Diabetic retinopathy graded by the modified Davis classification; 848x848: 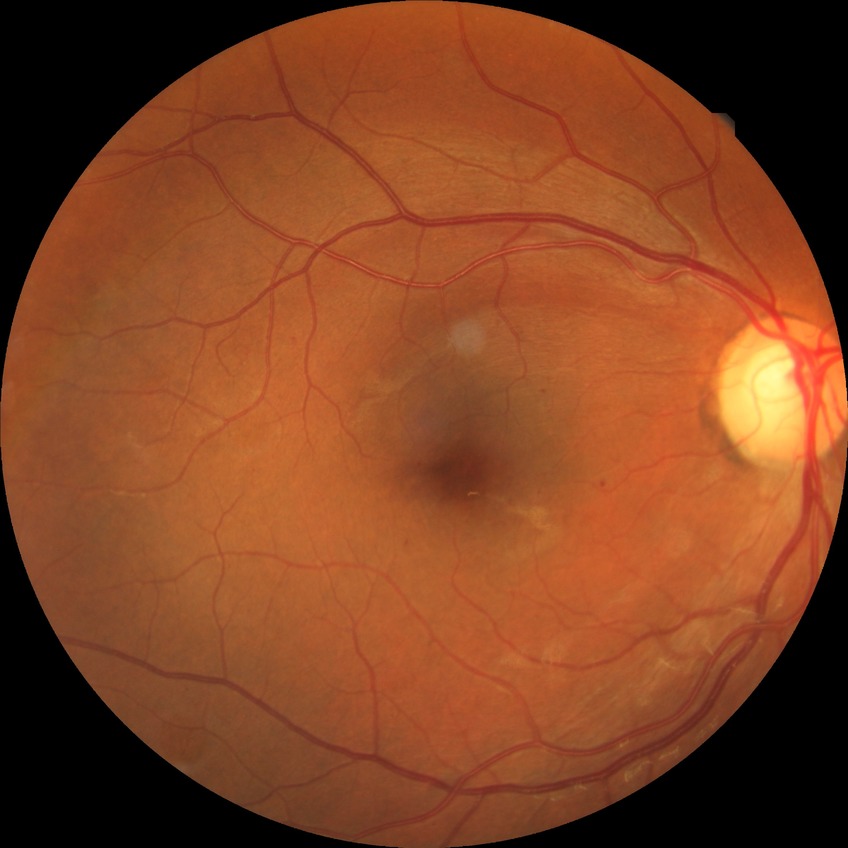
Retinopathy grade is simple diabetic retinopathy.